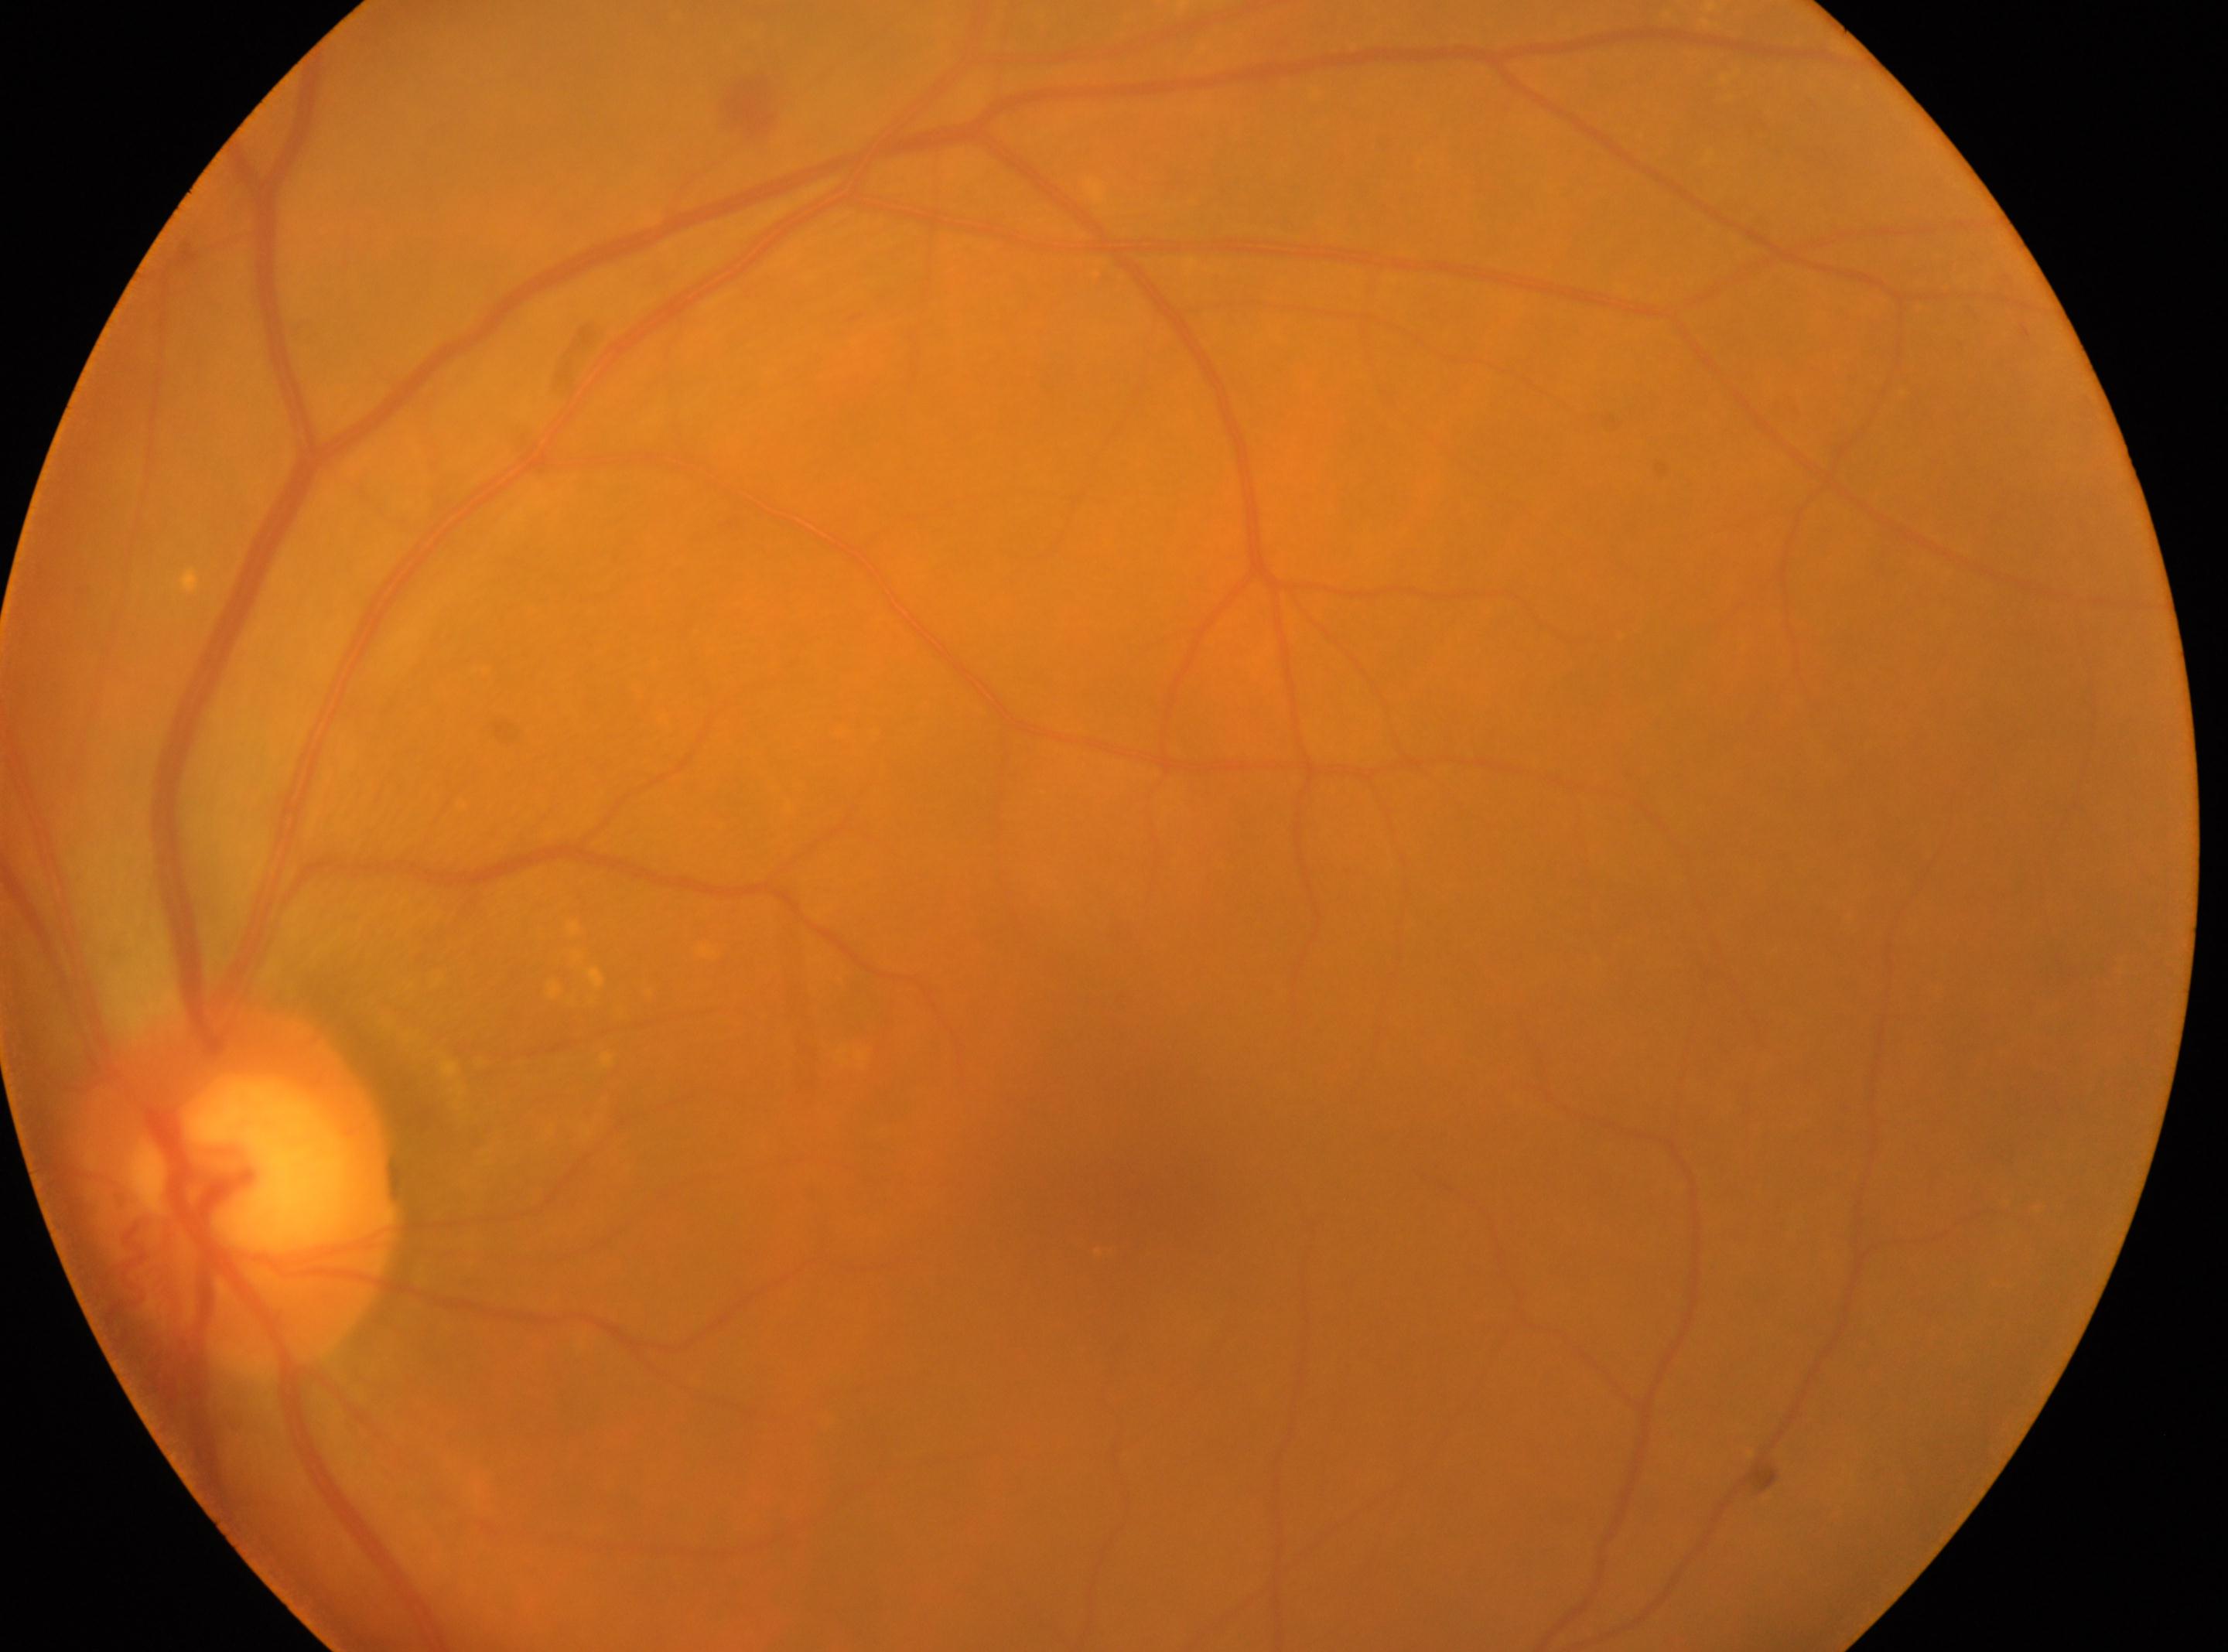

Imaged eye: oculus sinister. Macular center located at 1123px, 1182px. DR severity is moderate non-proliferative diabetic retinopathy (grade 2). The optic disk is at 234px, 1193px.